1932x1916
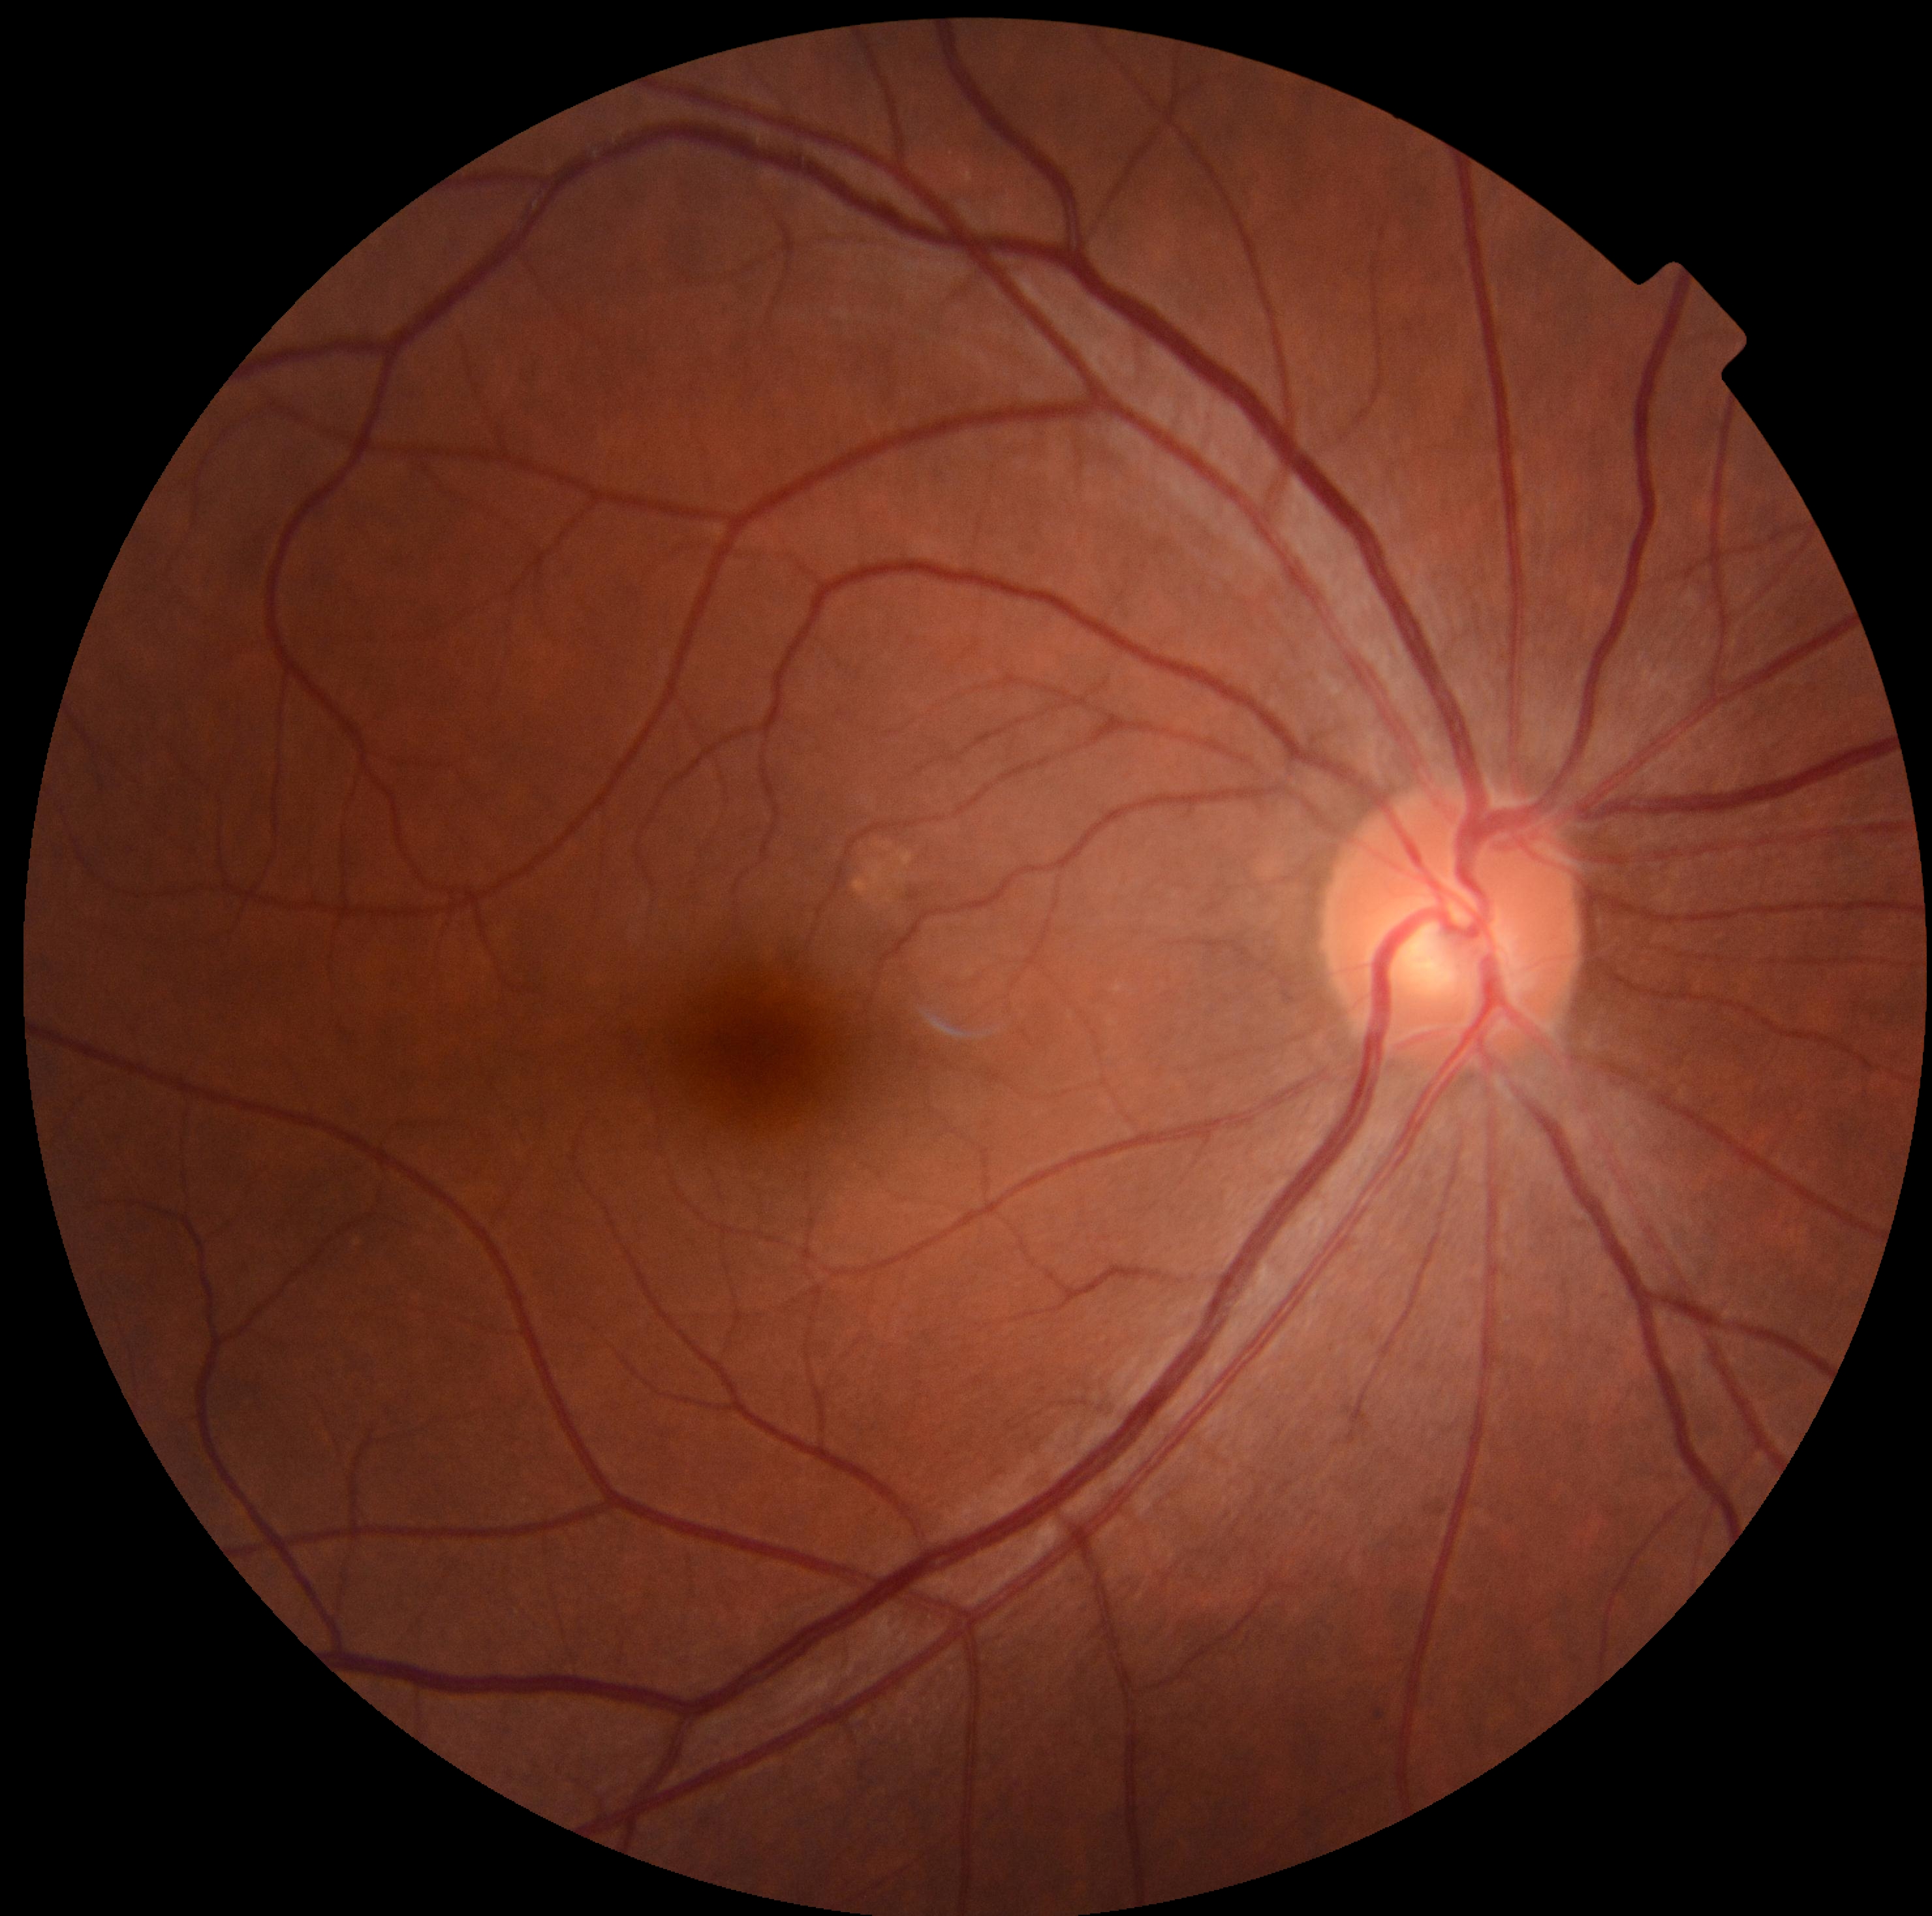

  dr_grade: 0